Ultra-widefield fundus mosaic
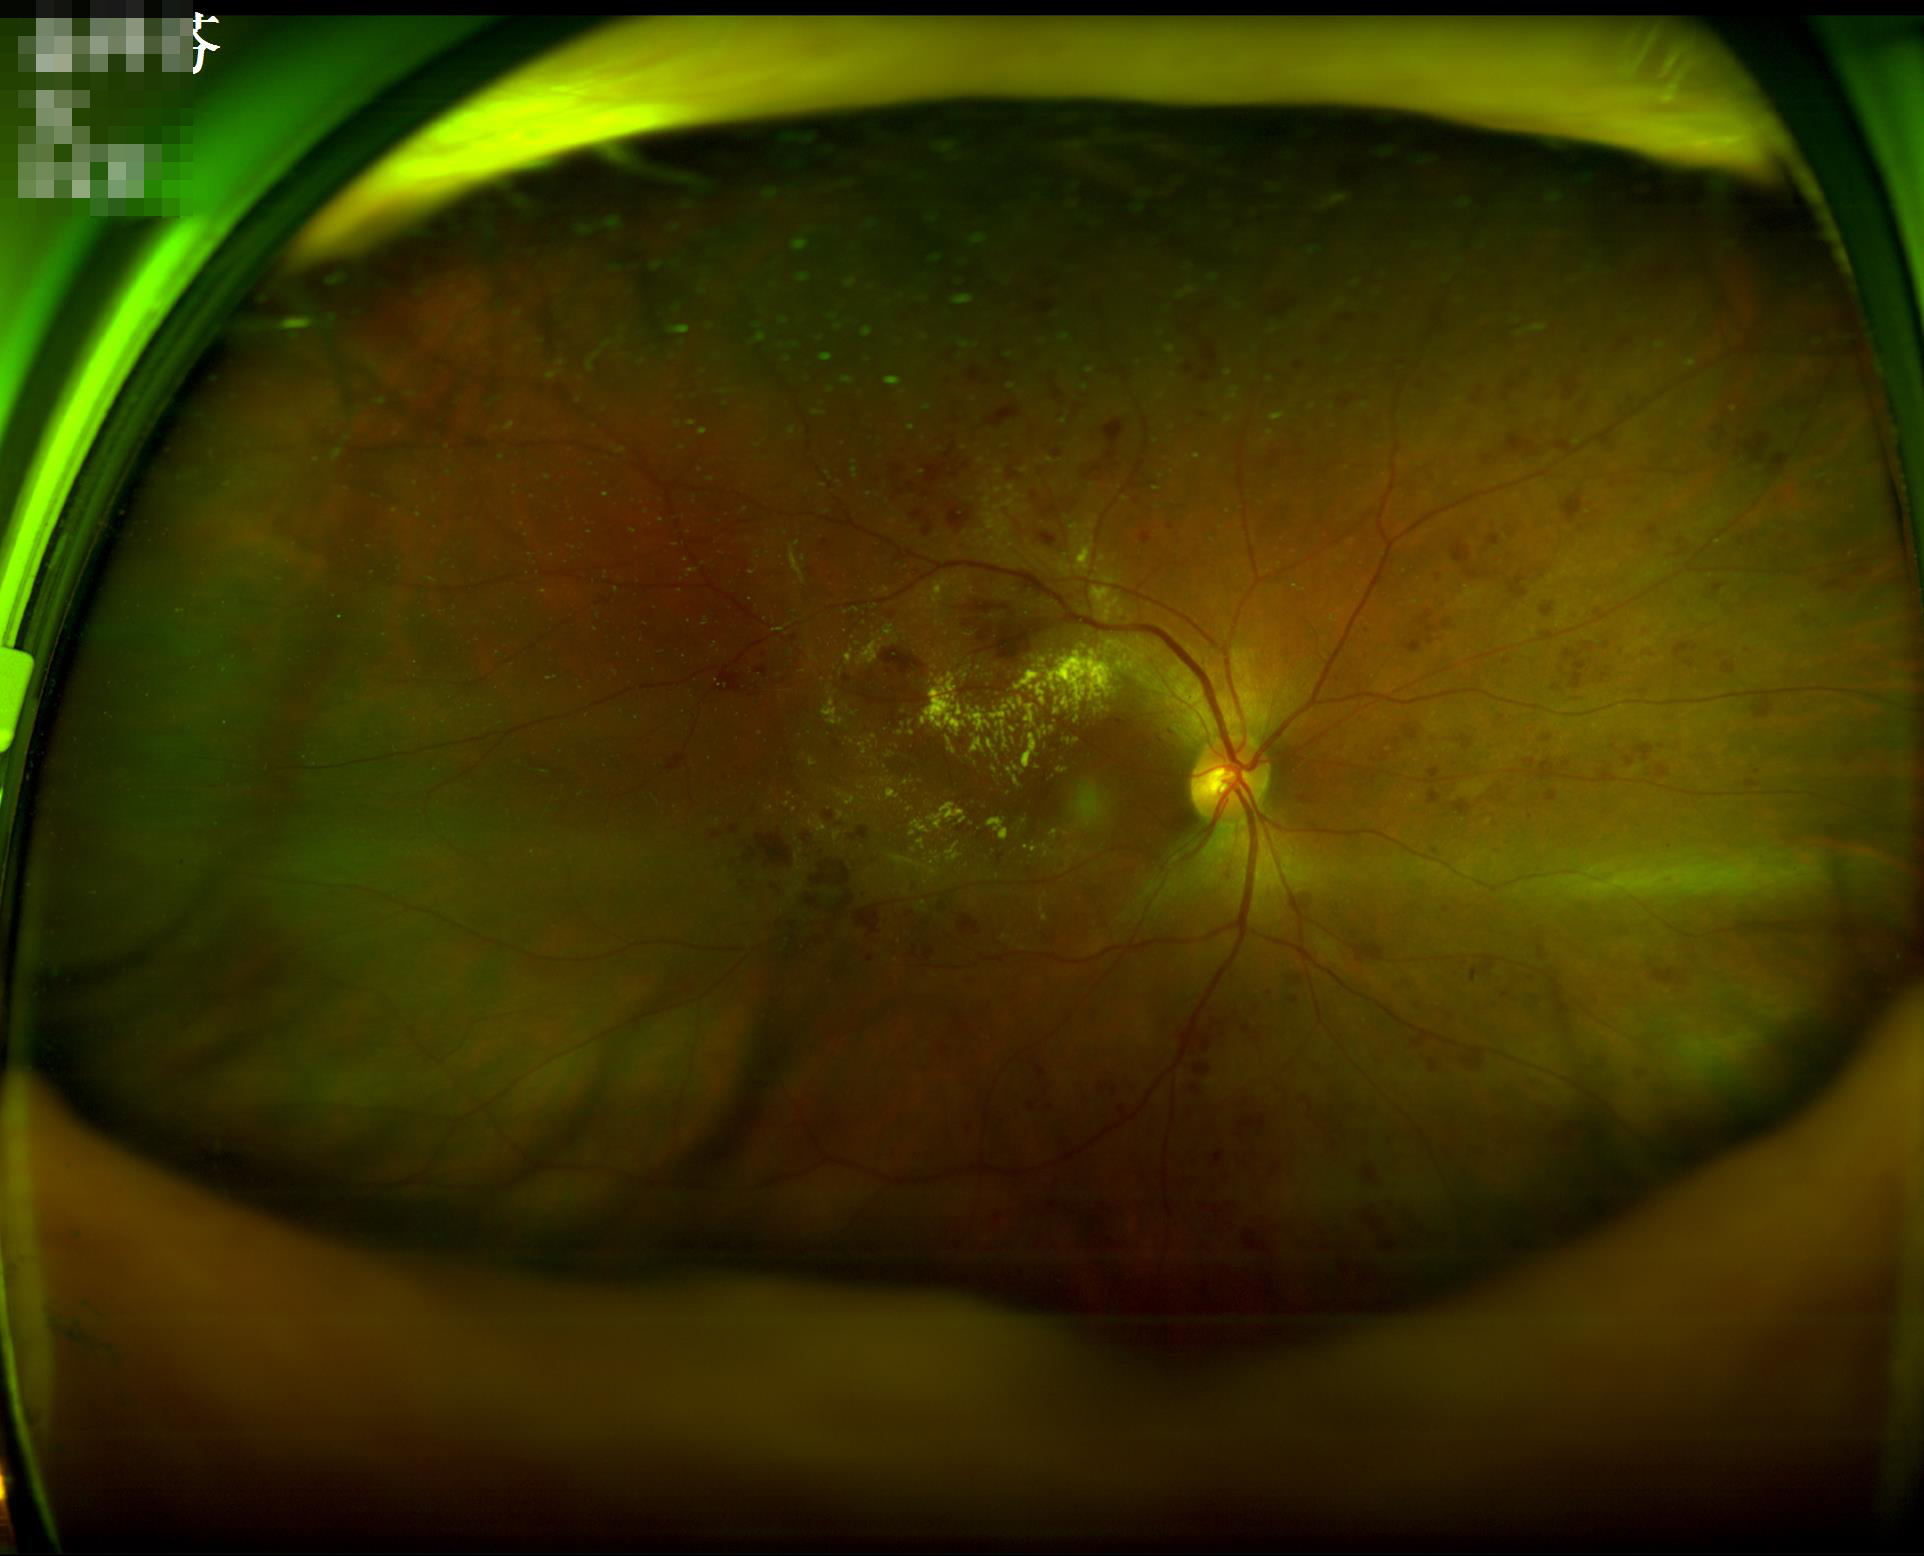 Good dynamic range. Acceptable image quality. No noticeable blur. Poor illumination with uneven exposure.